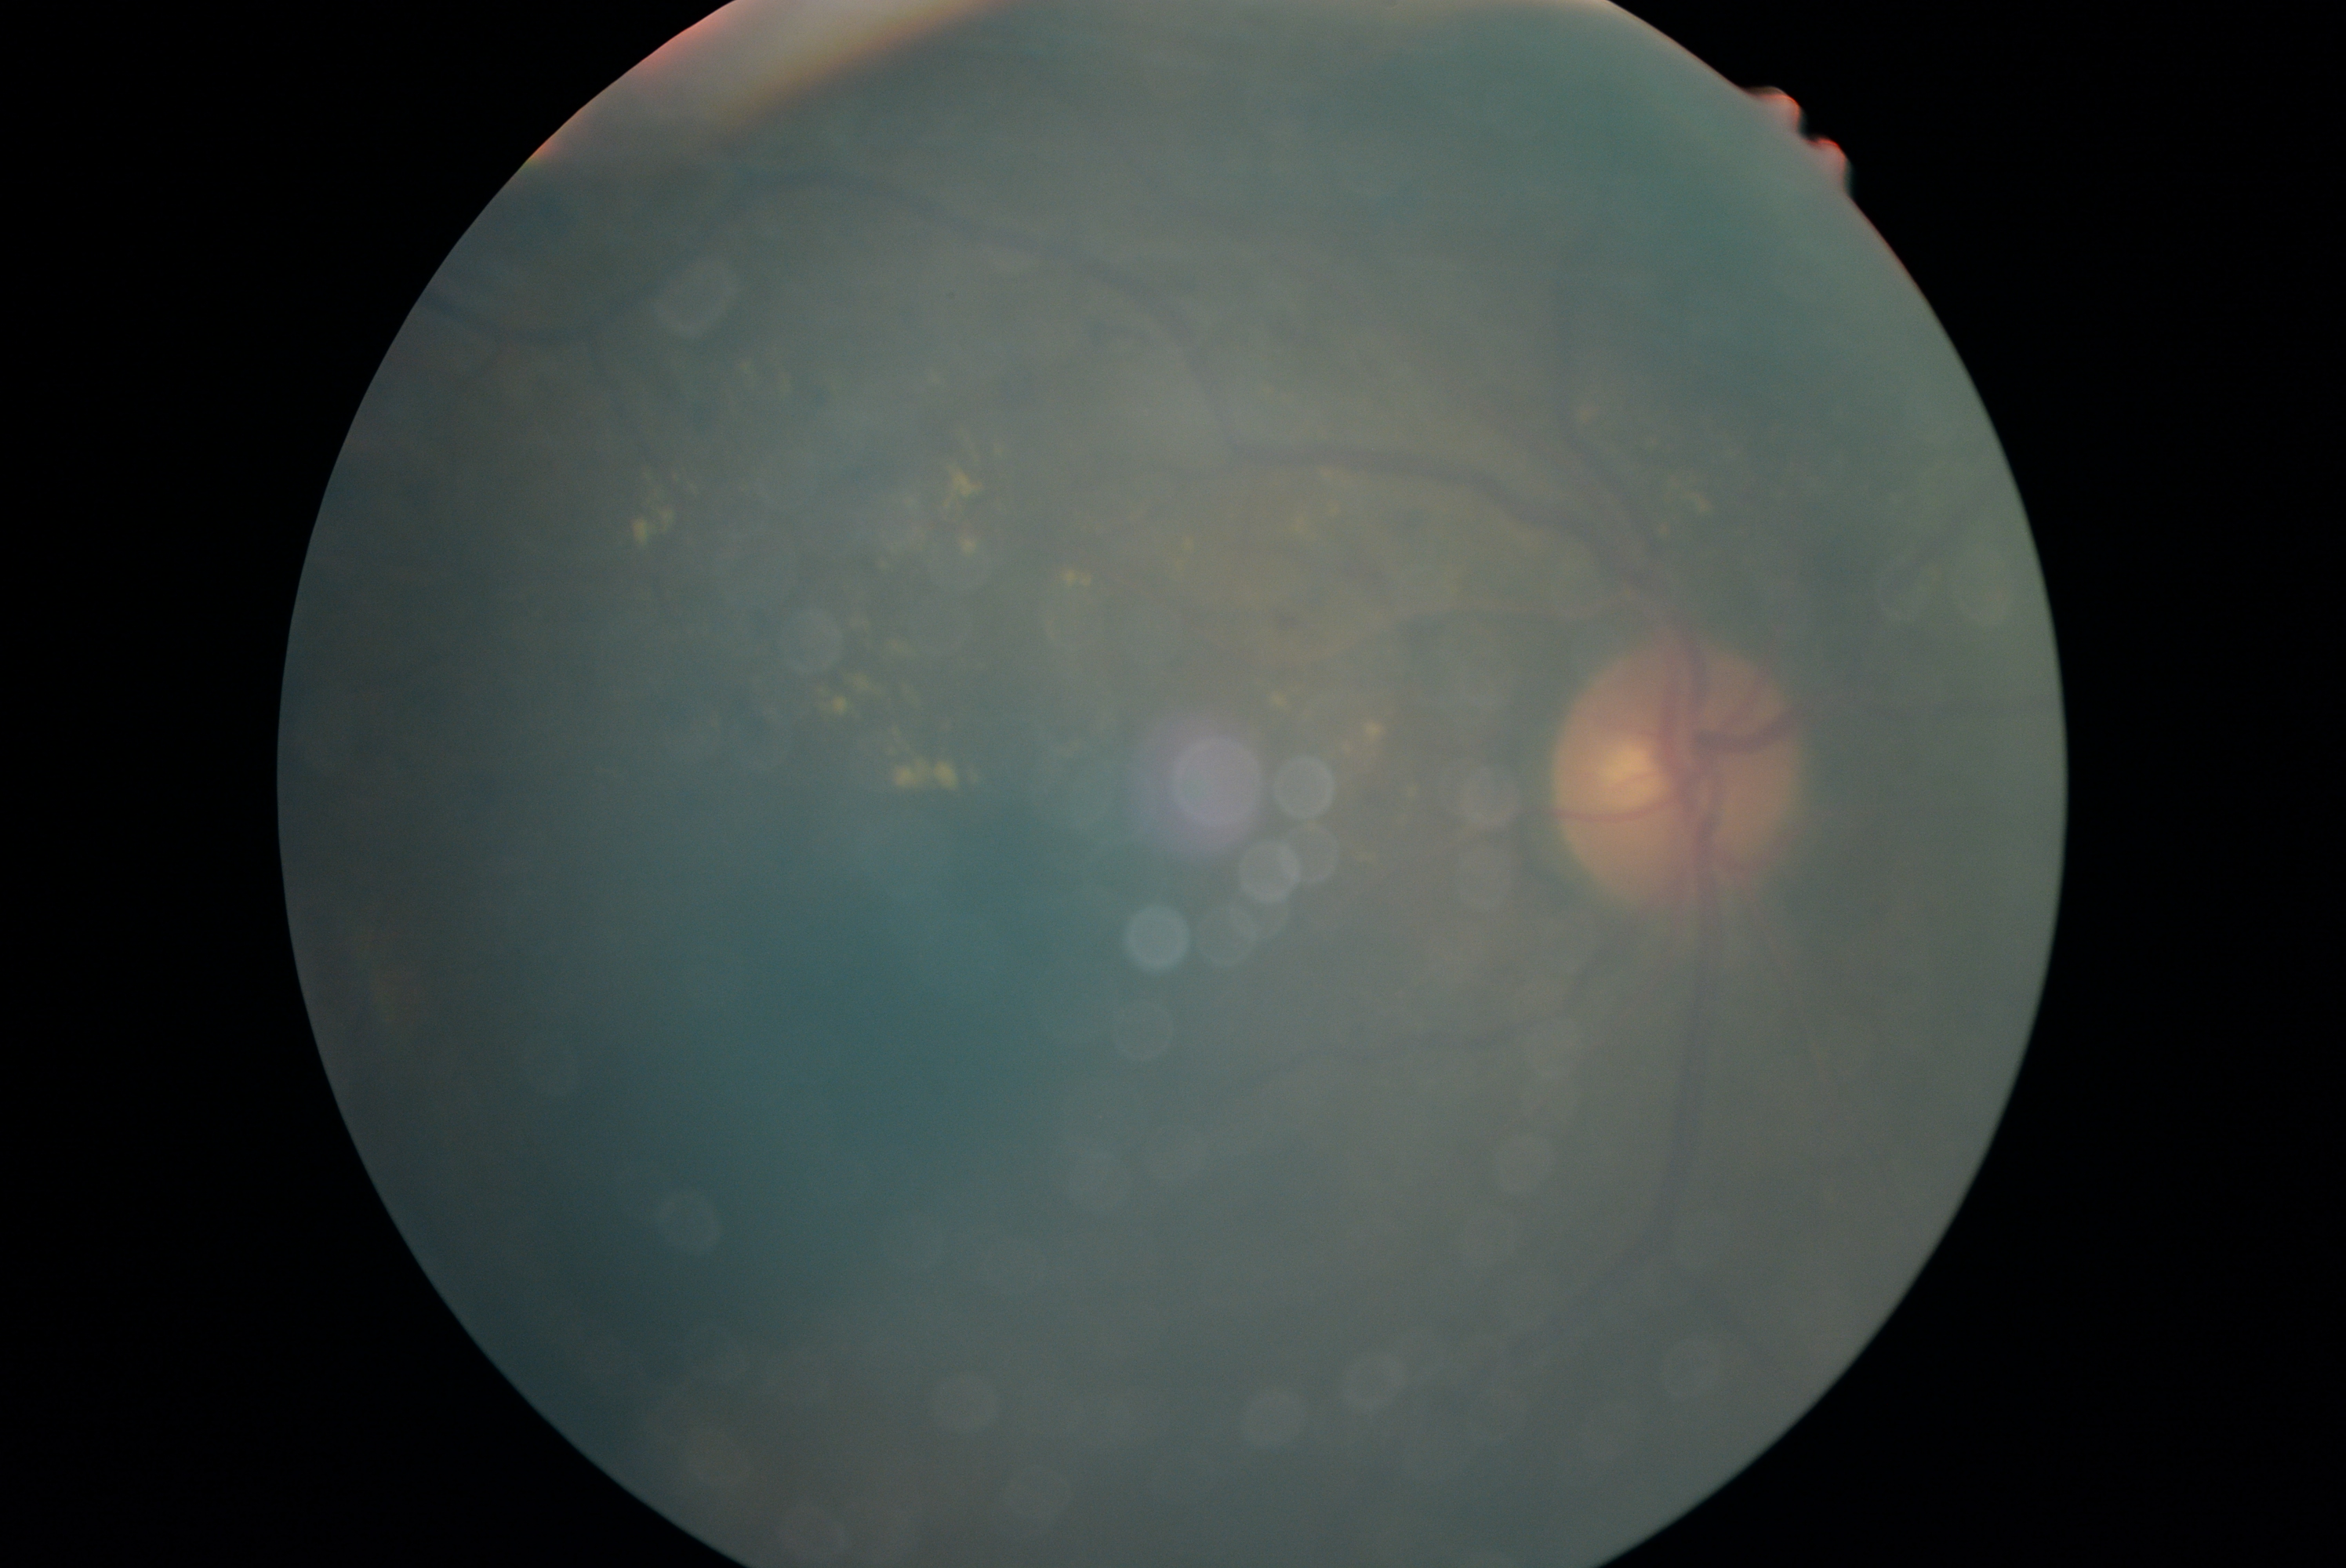

Annotations:
* diabetic retinopathy (DR) — grade 2 (moderate NPDR)